1440x1080 · wide-field fundus image from infant ROP screening · acquired on the Natus RetCam Envision
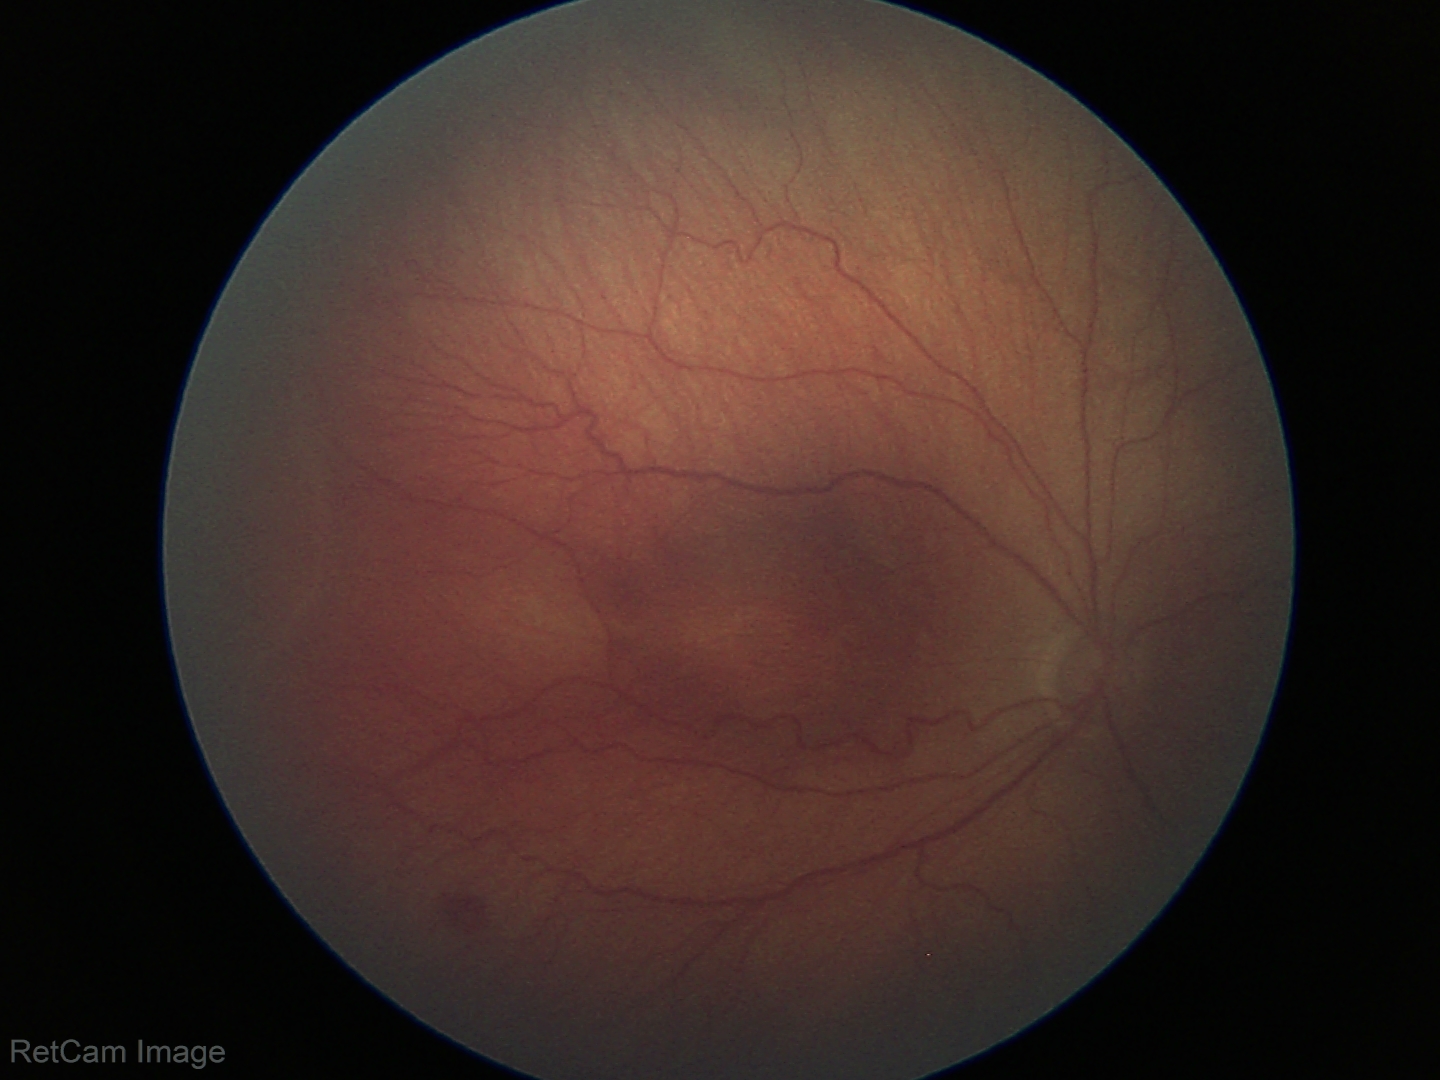
Screening examination consistent with ROP stage 3.